240 by 240 pixels — 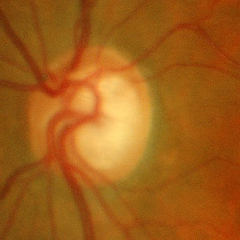

Fundus image with findings of early glaucomatous optic neuropathy.